Wide-field fundus photograph from neonatal ROP screening: 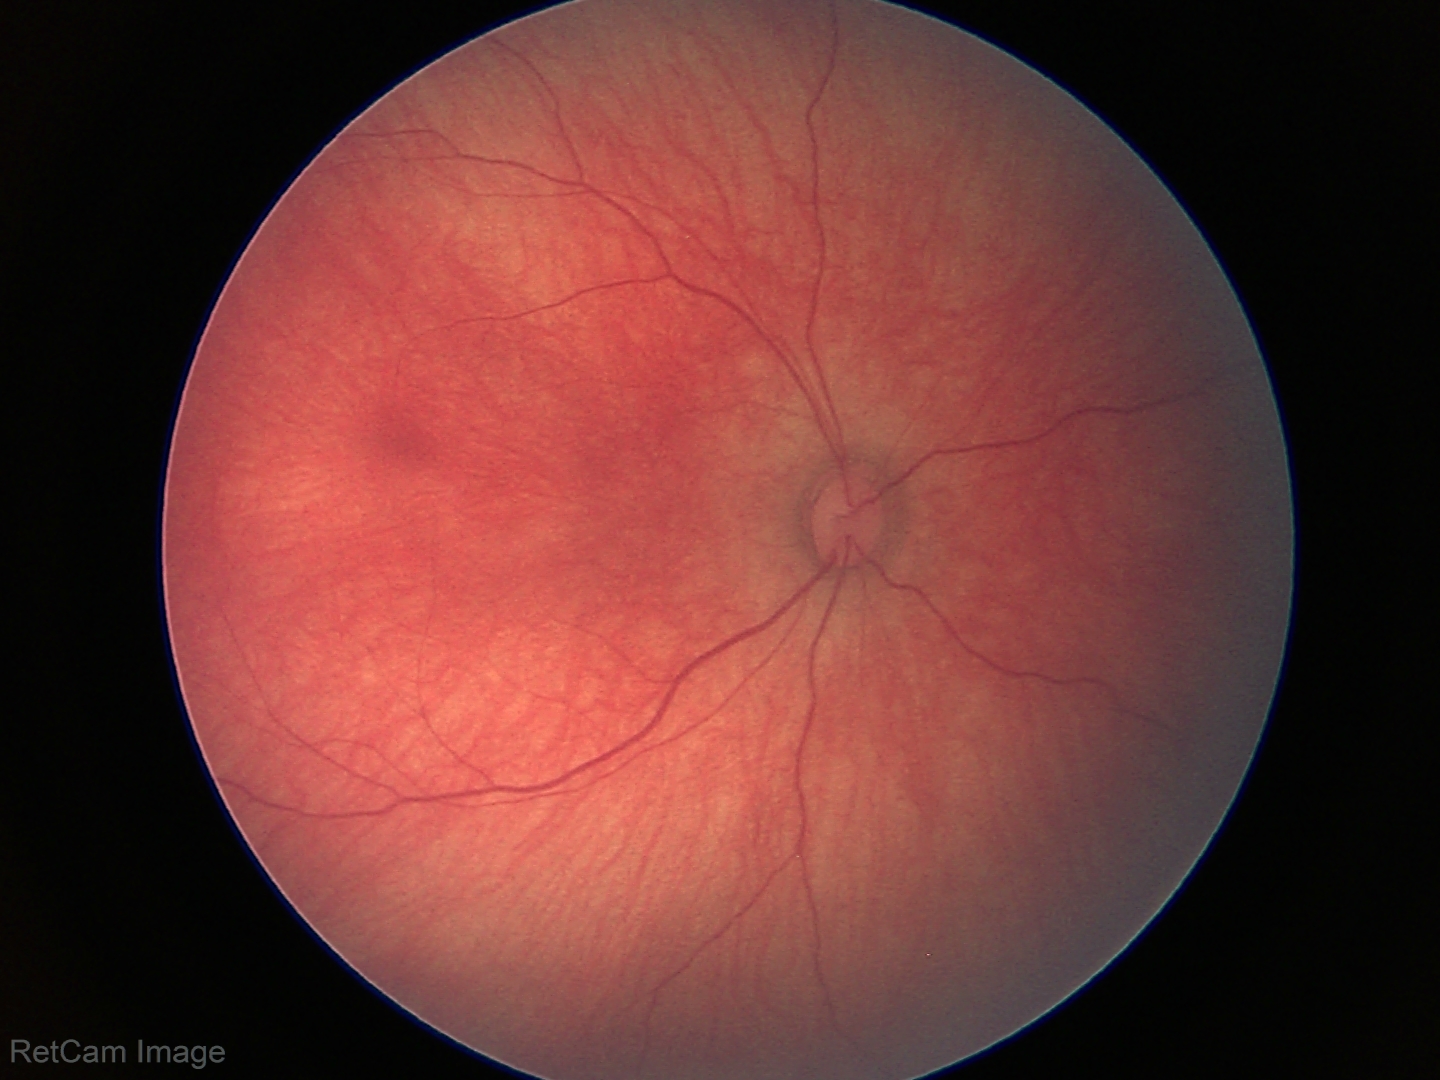

No retinal pathology identified on screening.